DR severity per modified Davis staging; FOV: 45 degrees:
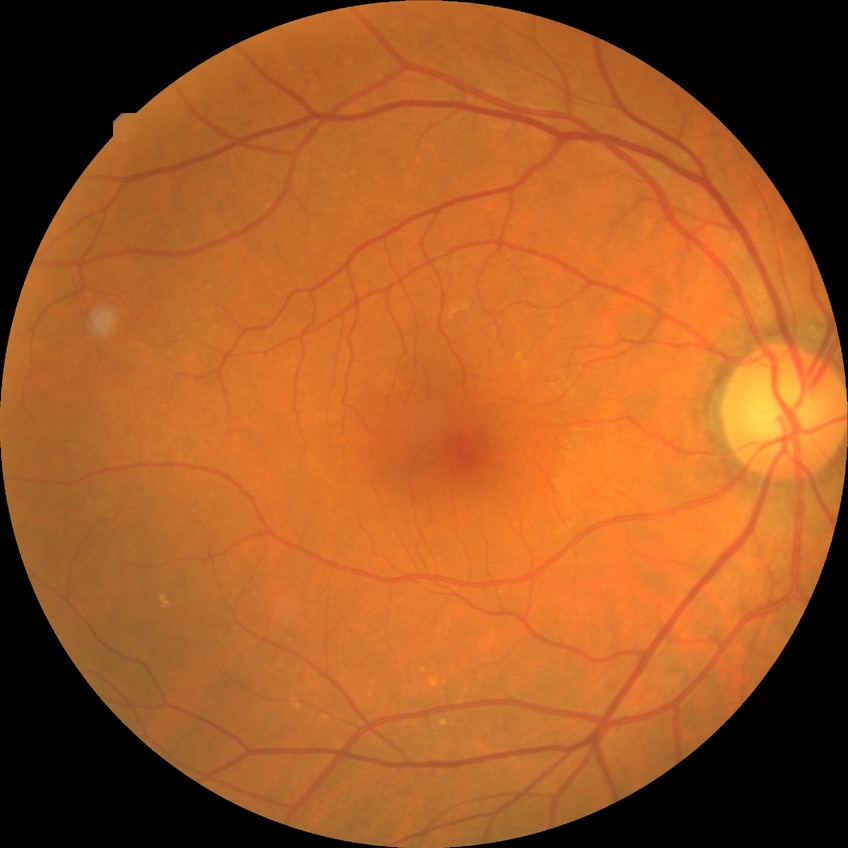

{
  "dr_impression": "no signs of DR",
  "davis_grade": "NDR"
}